Davis DR grading: 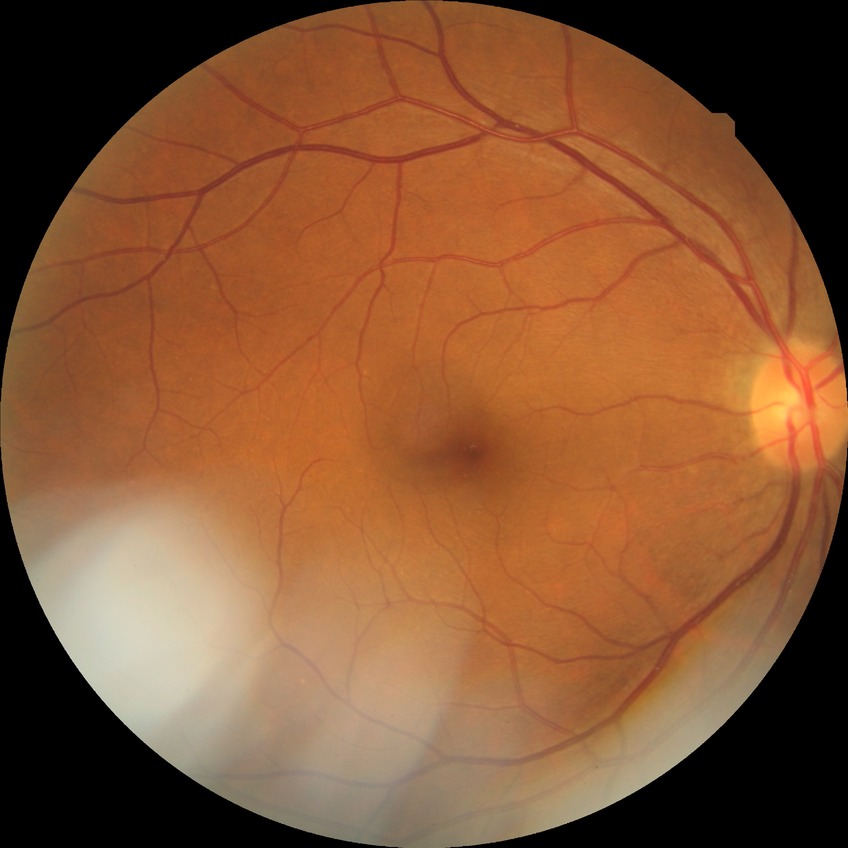 diabetic retinopathy (DR) = NDR (no diabetic retinopathy)